Retinal fundus photograph · 45° field of view · 2352x1568px — 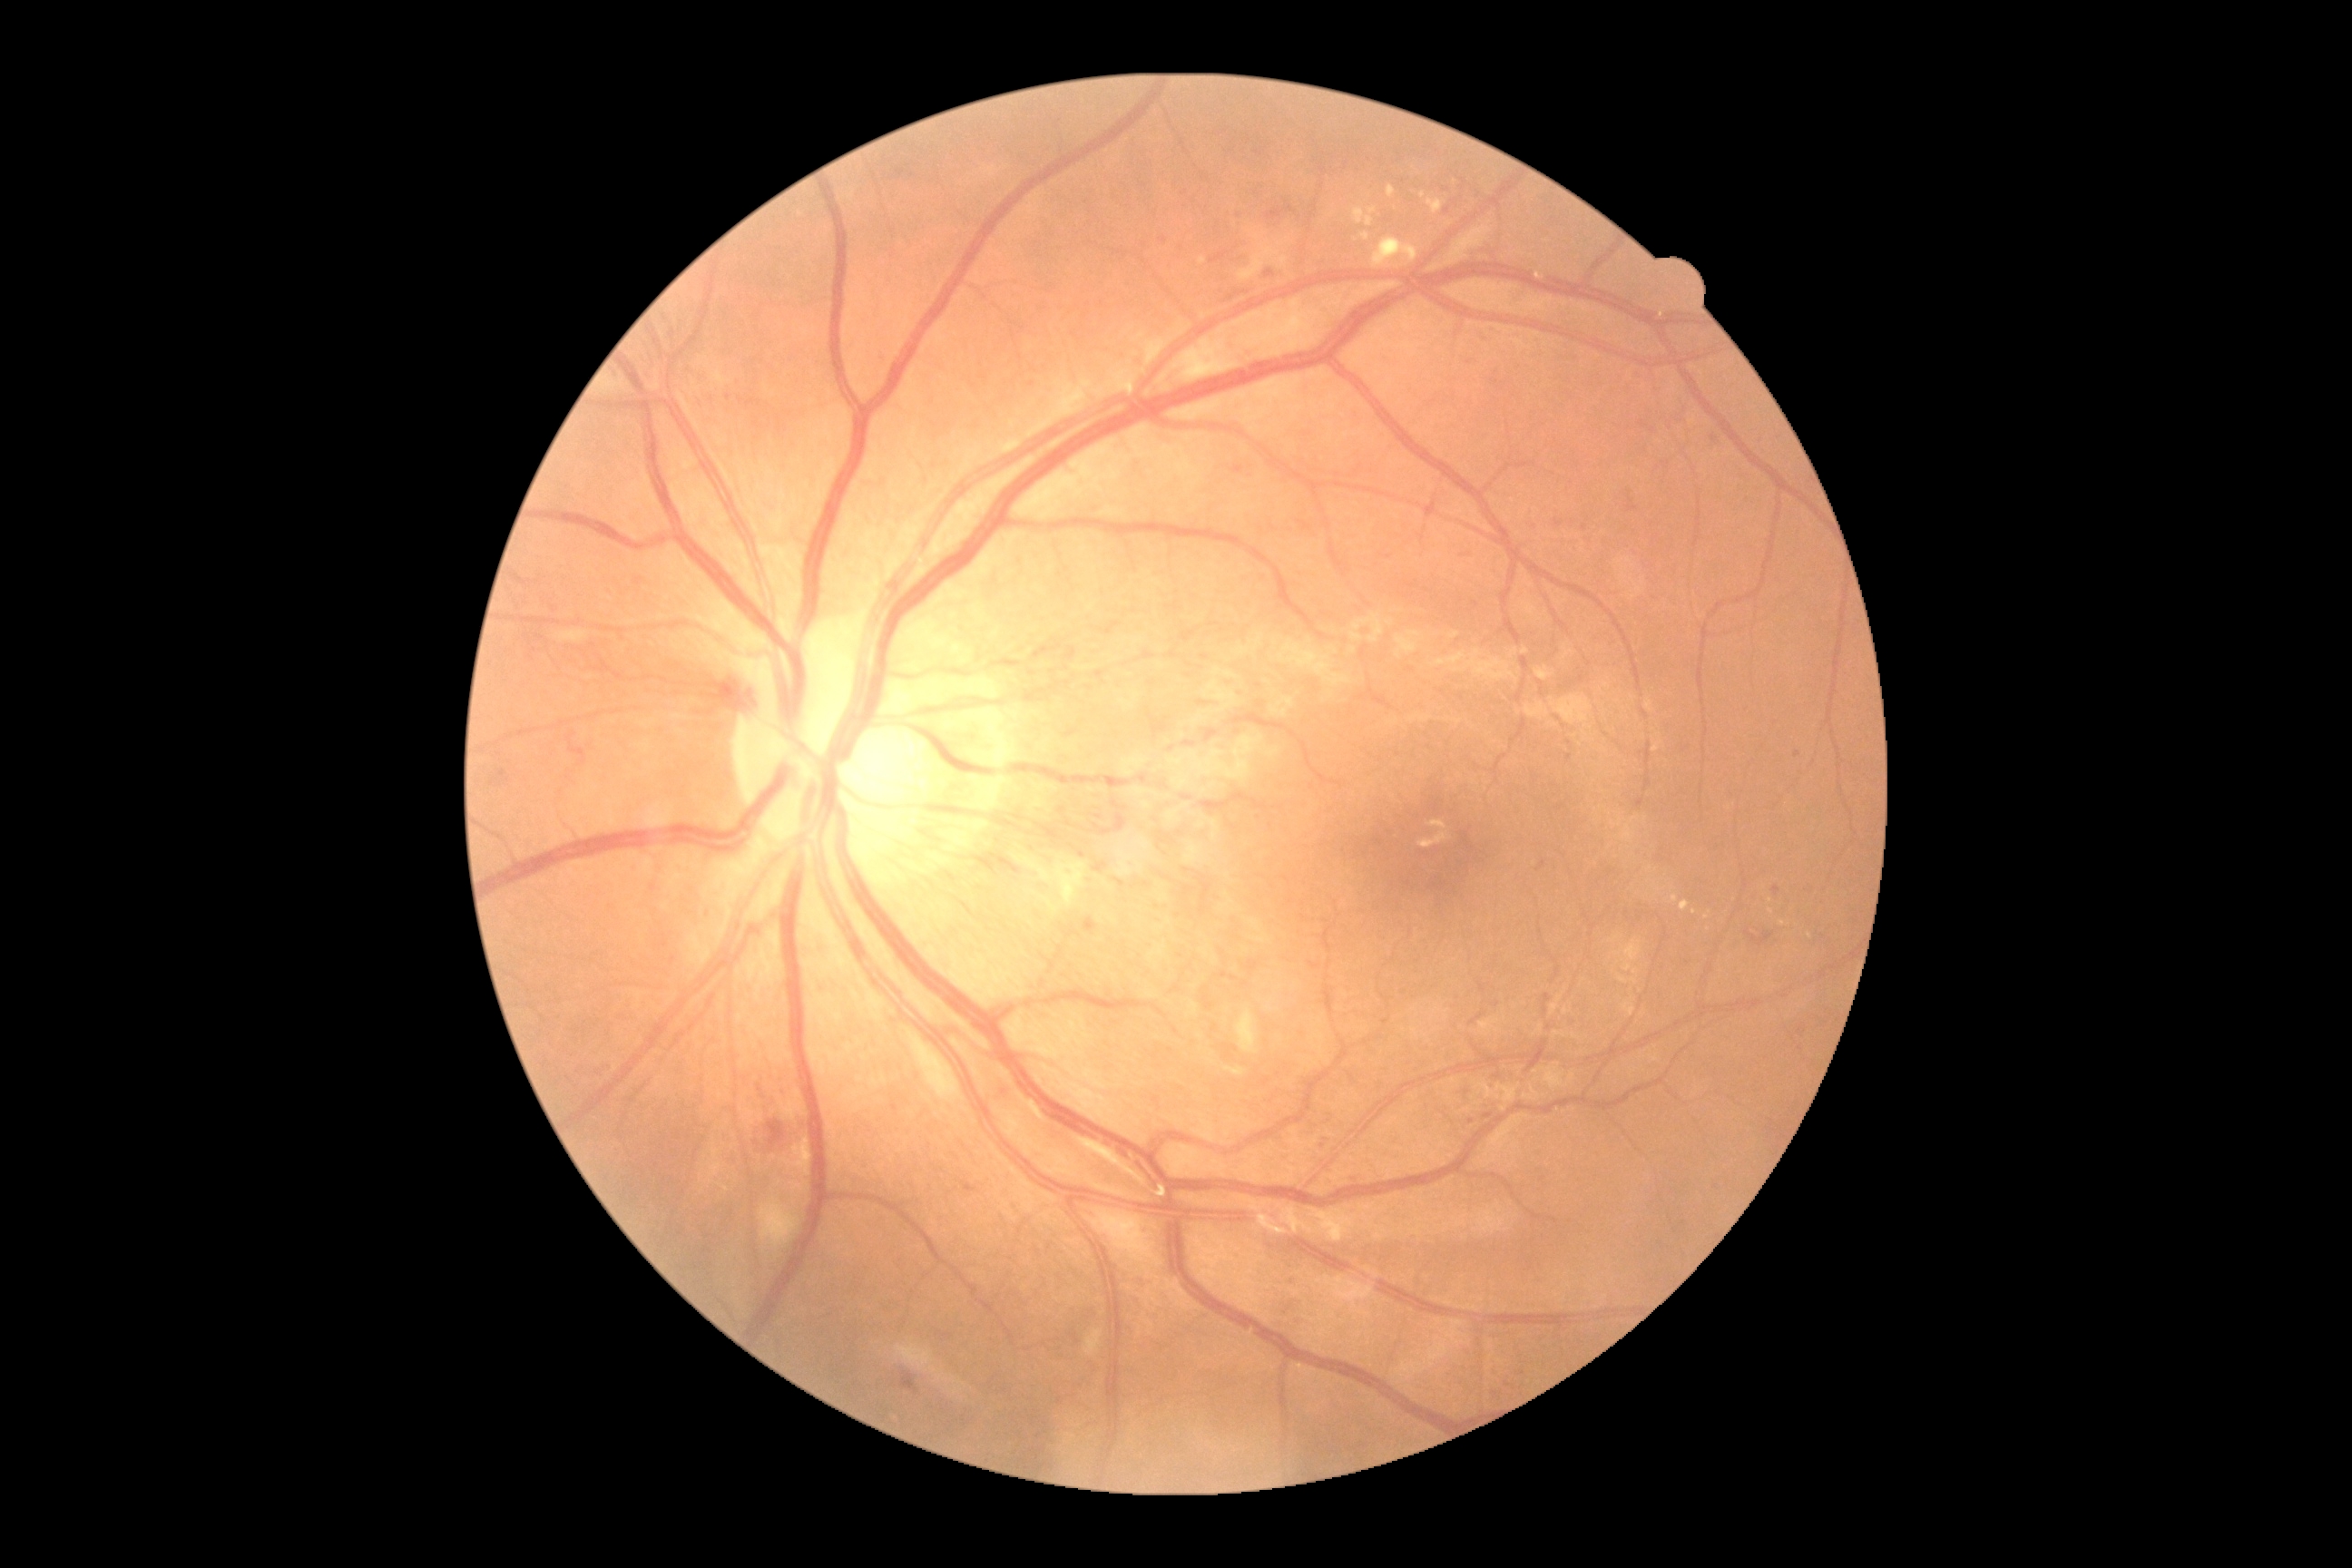 {"dr_grade": "grade 2 (moderate NPDR)"}